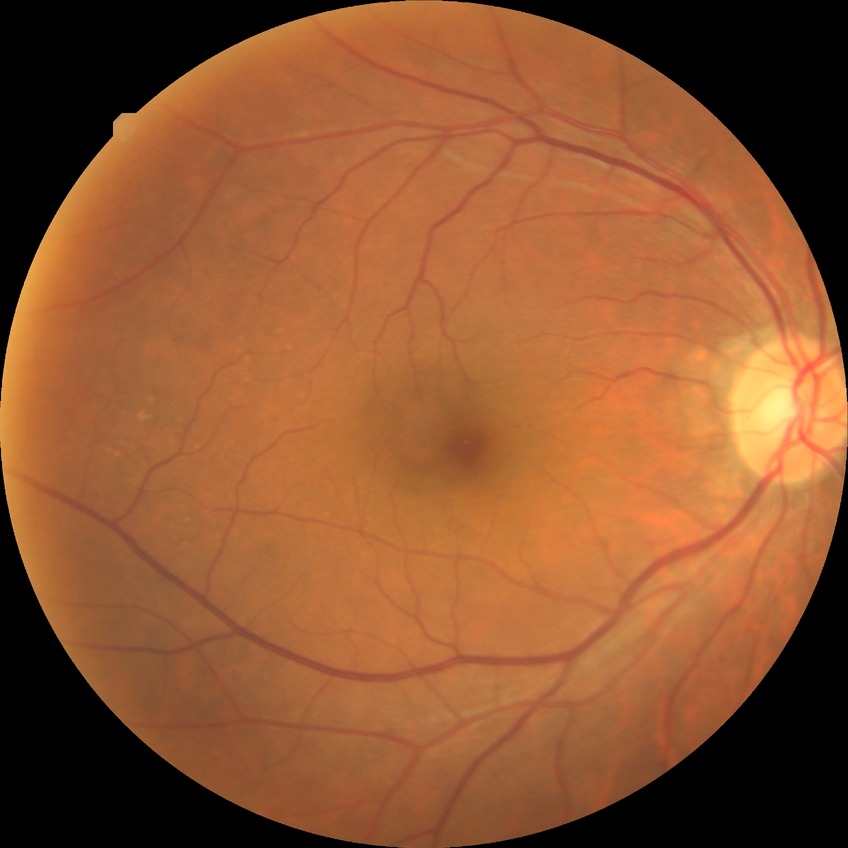
Findings:
* diabetic retinopathy severity: no diabetic retinopathy